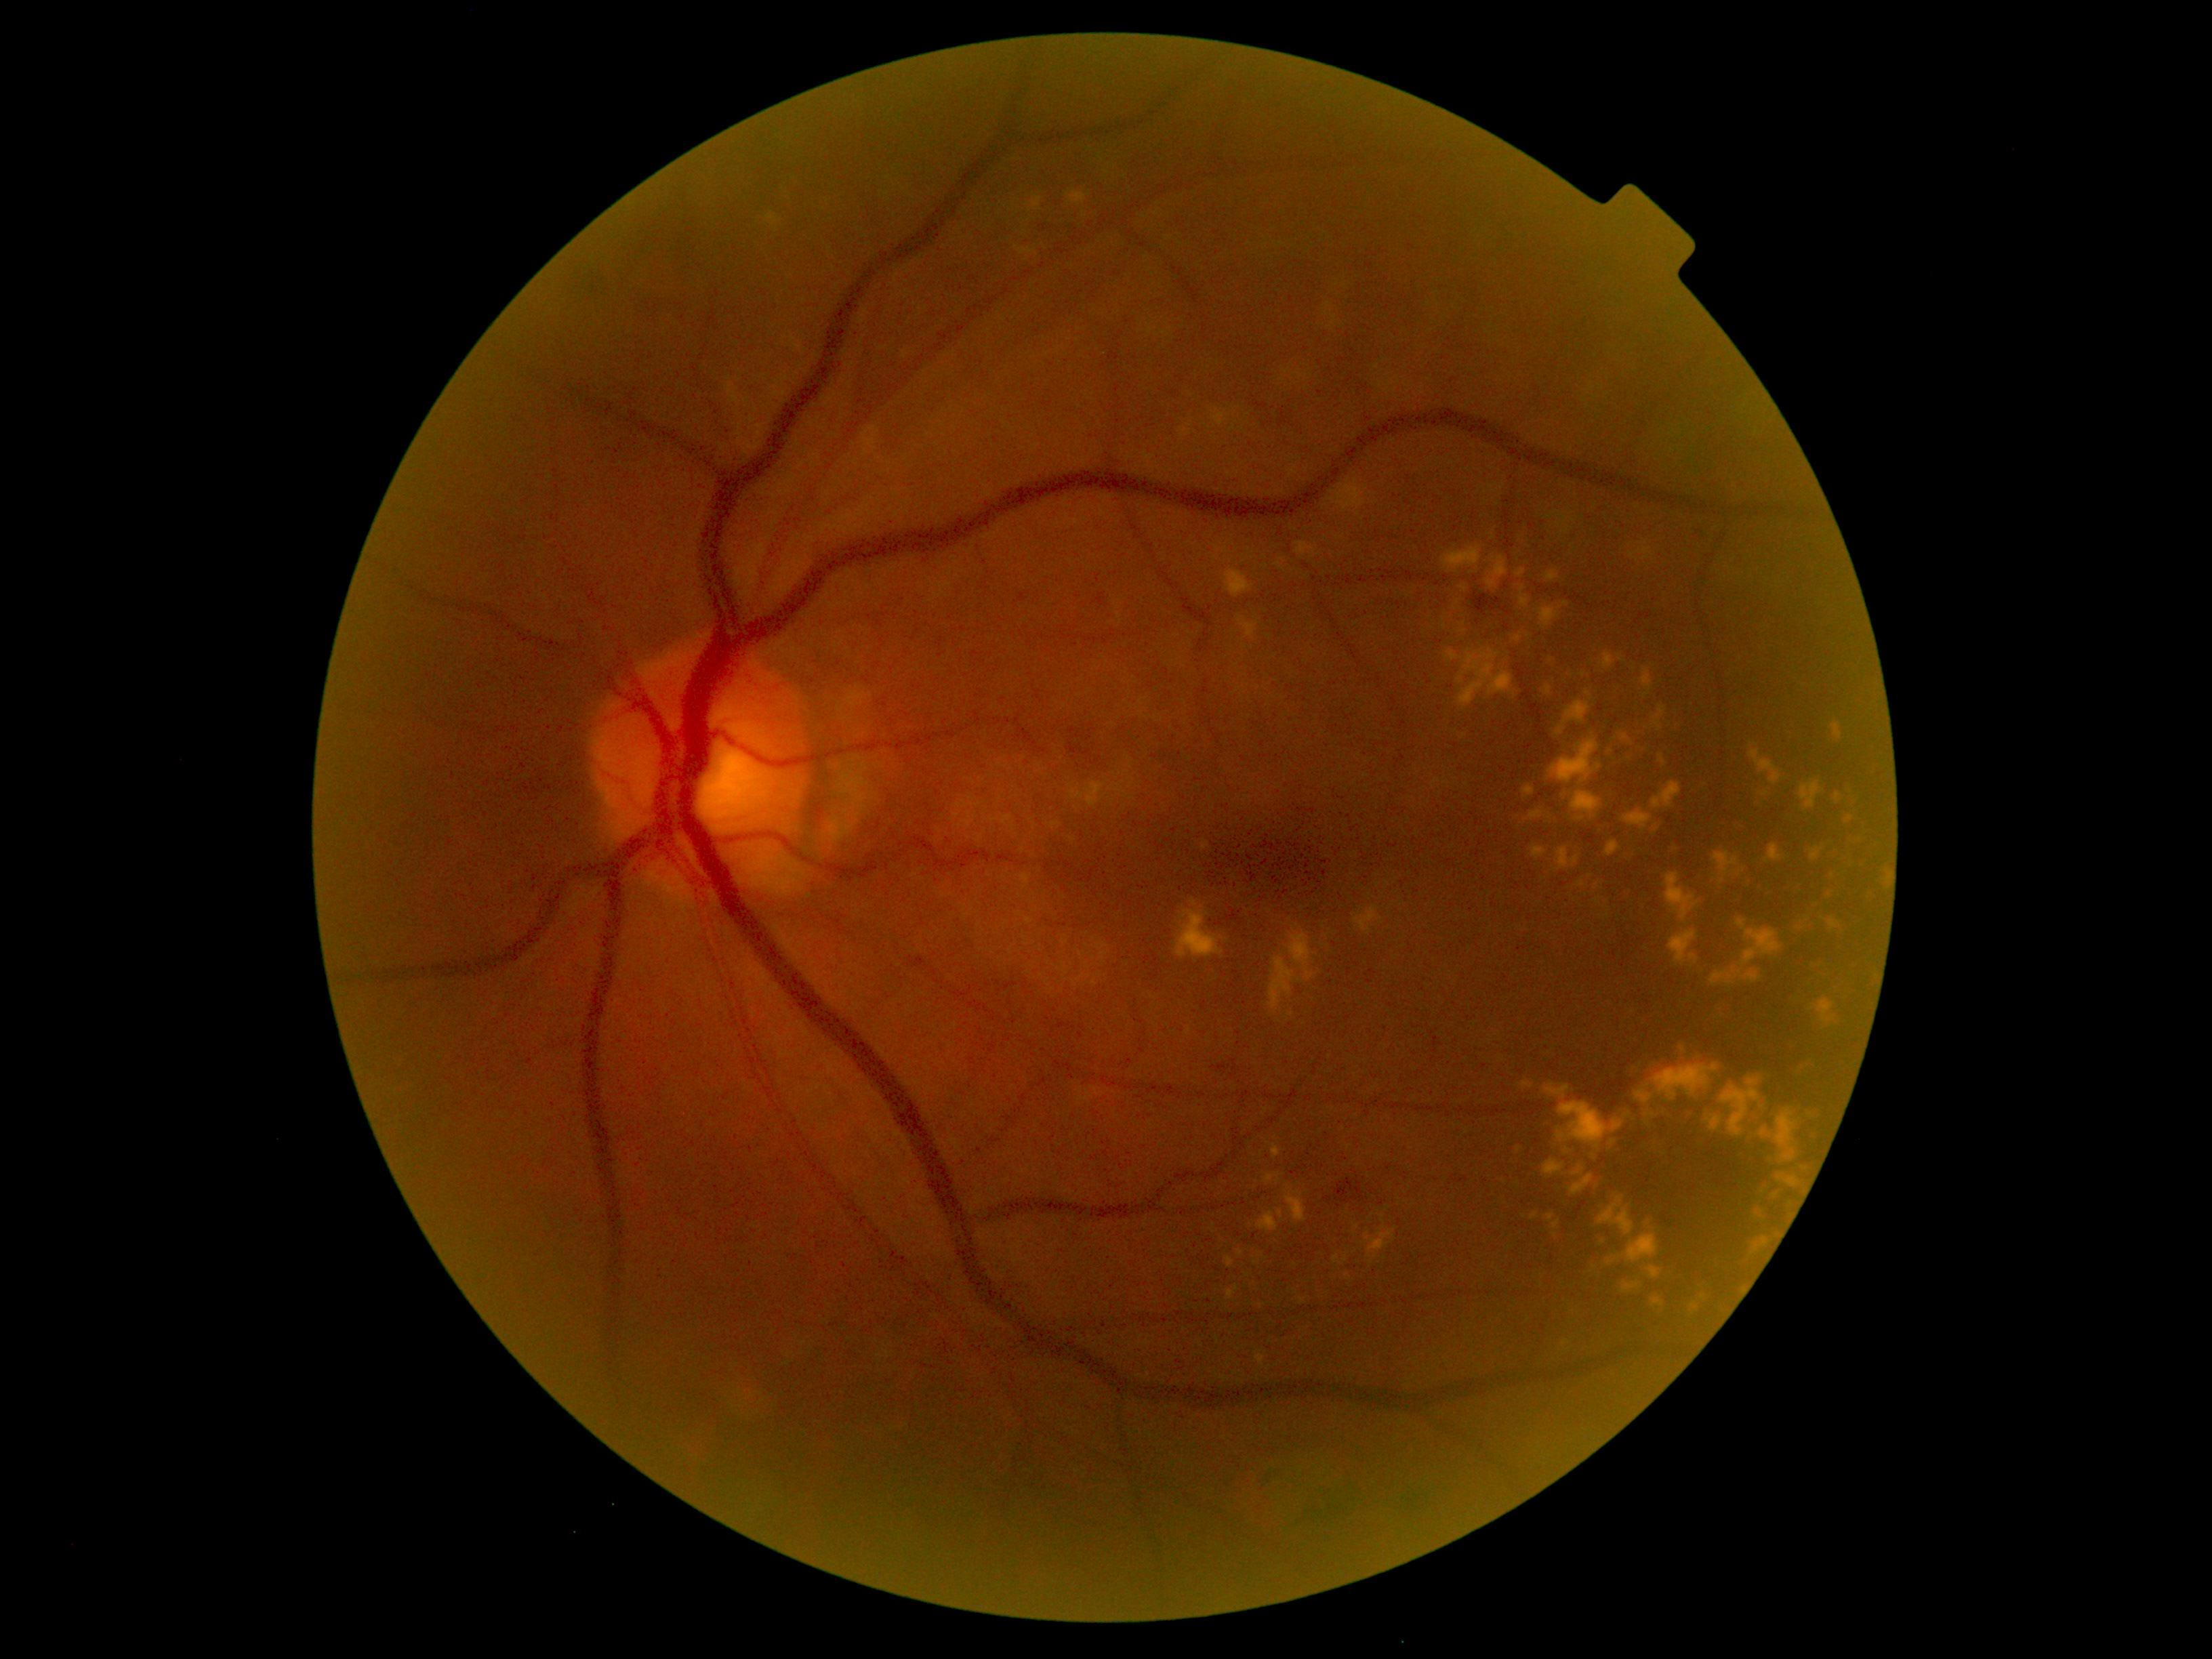 DR is moderate NPDR (grade 2)
Representative lesions:
EXs (continued): <region>1286, 1187, 1307, 1222</region> | <region>1544, 1160, 1566, 1176</region> | <region>1546, 571, 1559, 582</region> | <region>1257, 1212, 1279, 1233</region> | <region>1562, 1341, 1570, 1347</region> | <region>1180, 422, 1193, 440</region> | <region>1738, 918, 1782, 967</region> | <region>1015, 246, 1038, 255</region> | <region>1710, 968, 1761, 987</region> | <region>1268, 933, 1317, 1012</region> | <region>1729, 825, 1746, 836</region> | <region>1382, 1215, 1385, 1225</region> | <region>1557, 701, 1591, 735</region> | <region>1714, 852, 1738, 875</region> | <region>1276, 559, 1286, 571</region> | <region>1226, 1257, 1234, 1268</region>
EXs (small, approximate centers) near (1565,796) | (1357,1227) | (1838,796) | (1278,1182)